FOV: 200 degrees · ultra-widefield fundus mosaic
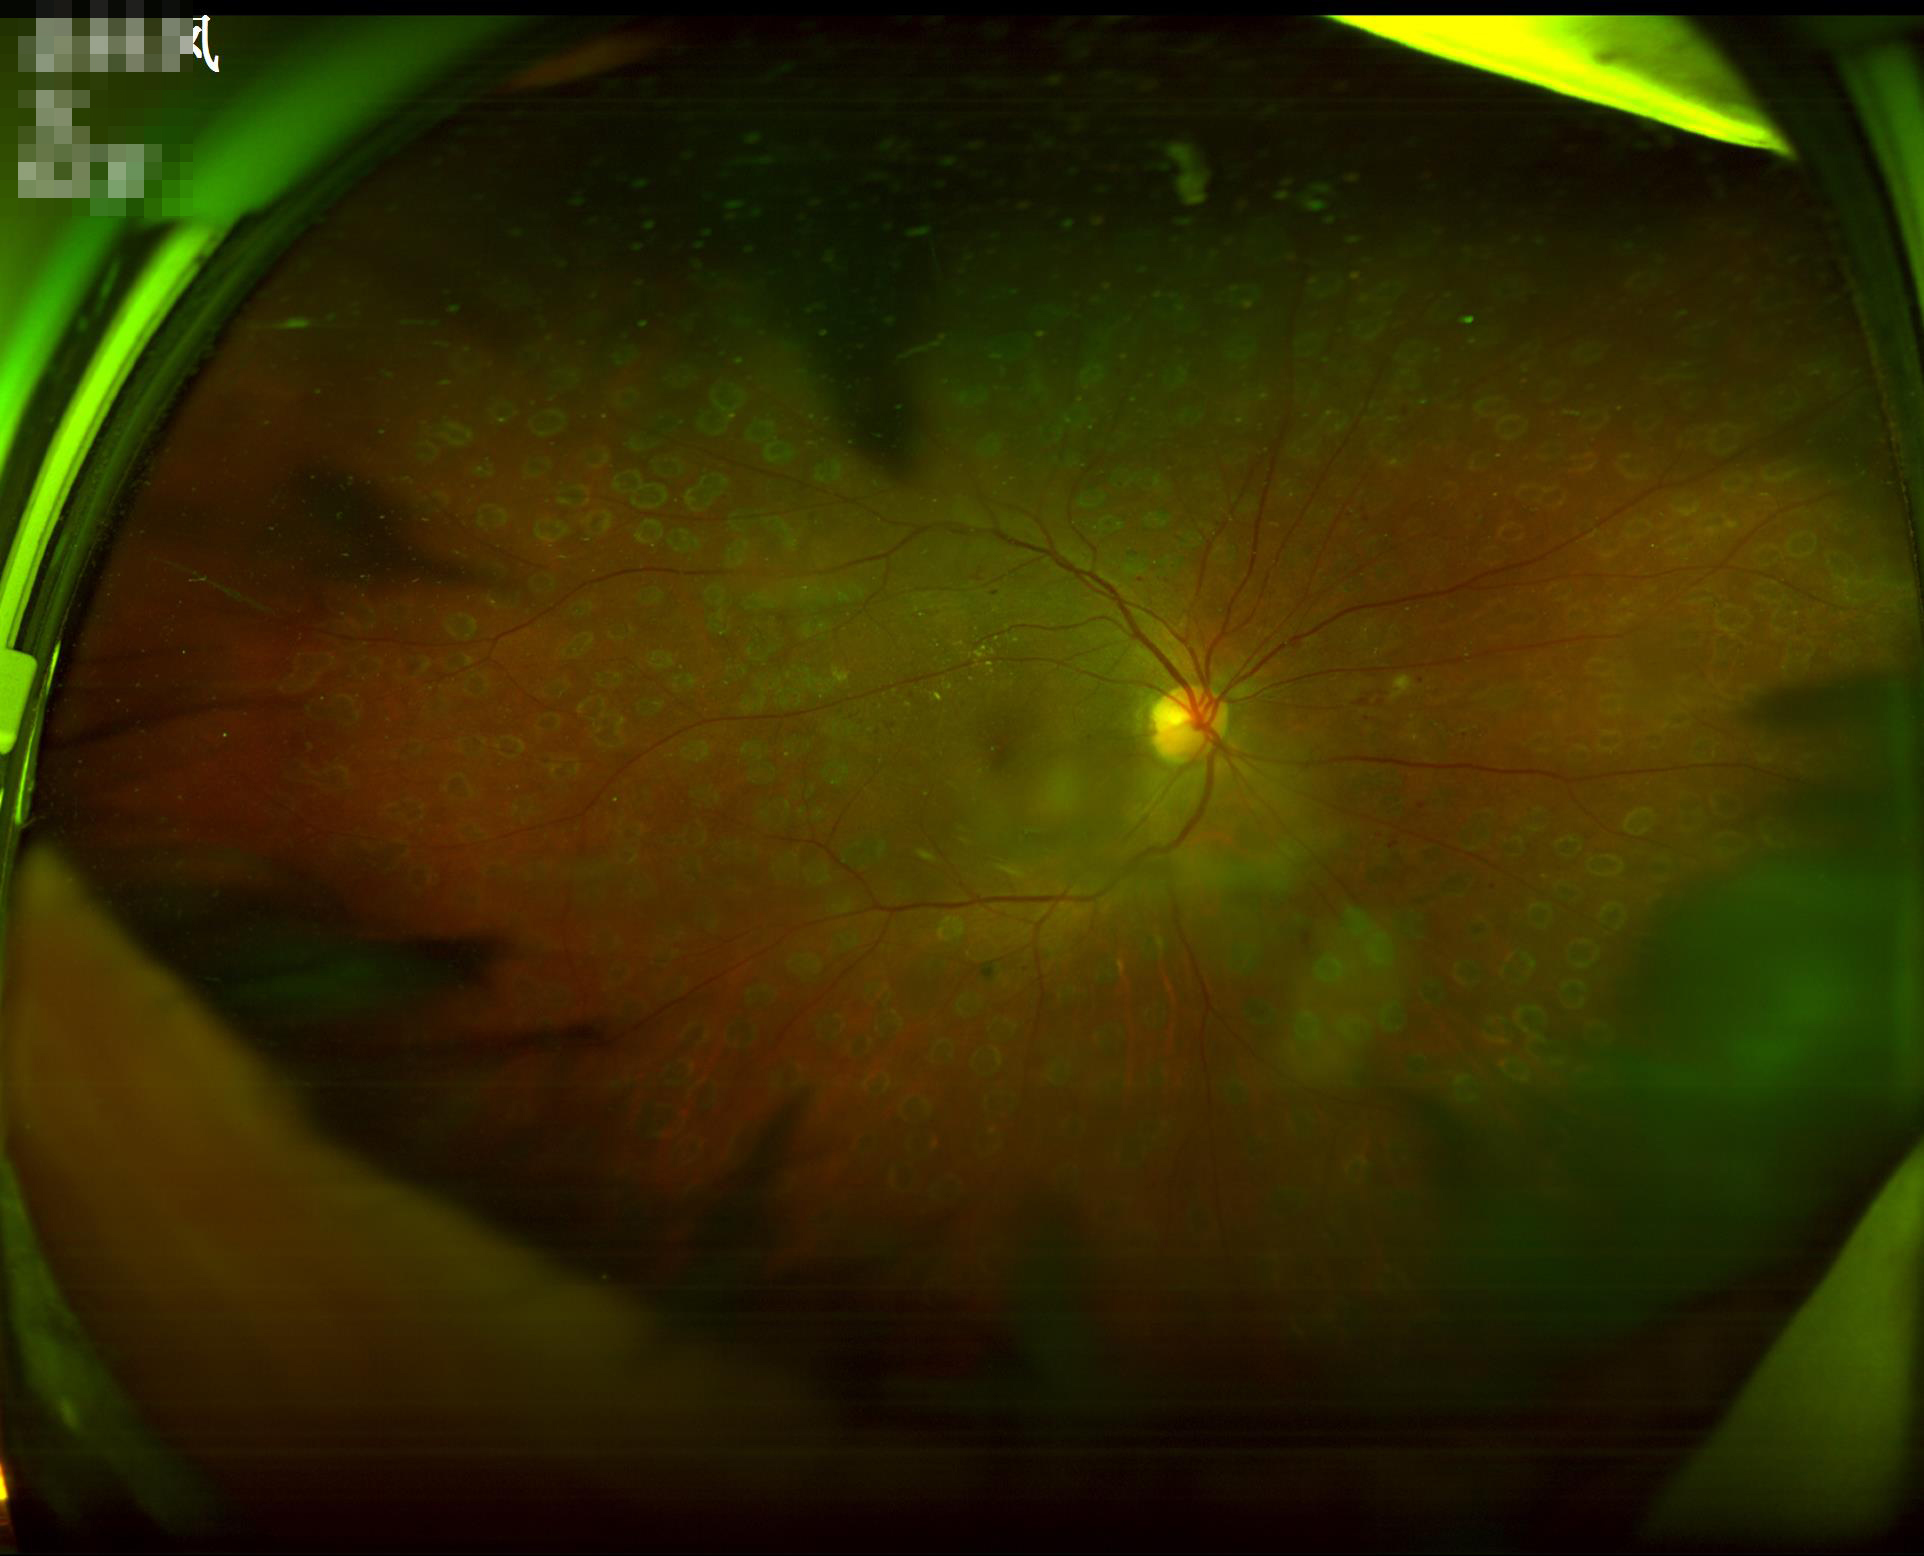 Illumination is uneven.
Contrast is good.
Acceptable image quality.
Optic disc, vessels, and background are in focus.